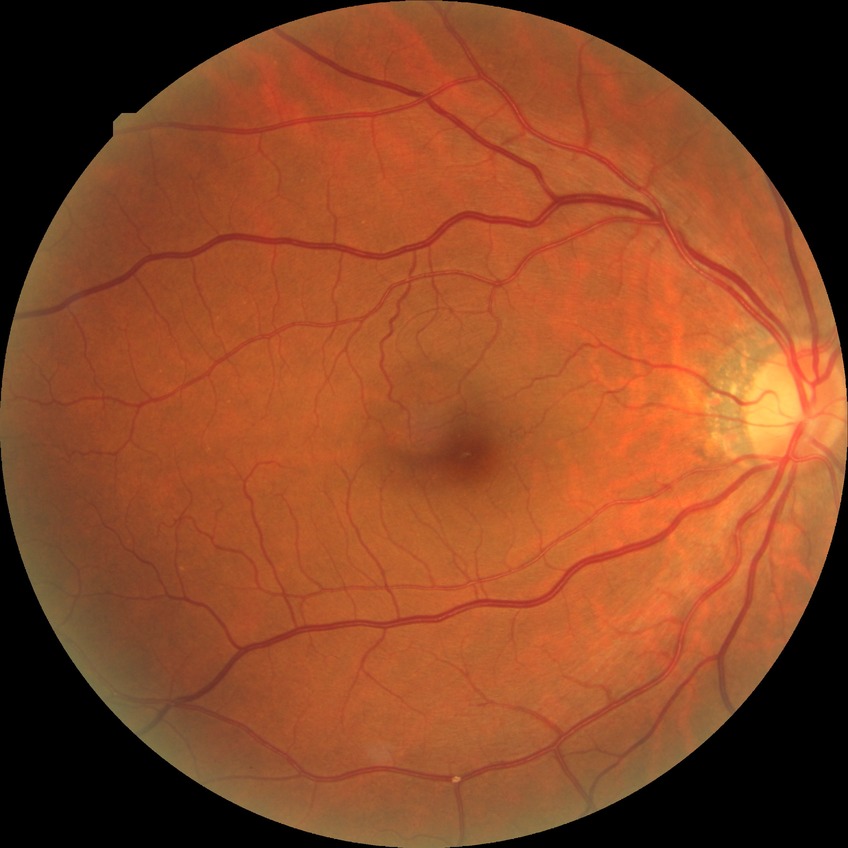

Diabetic retinopathy severity: simple diabetic retinopathy.